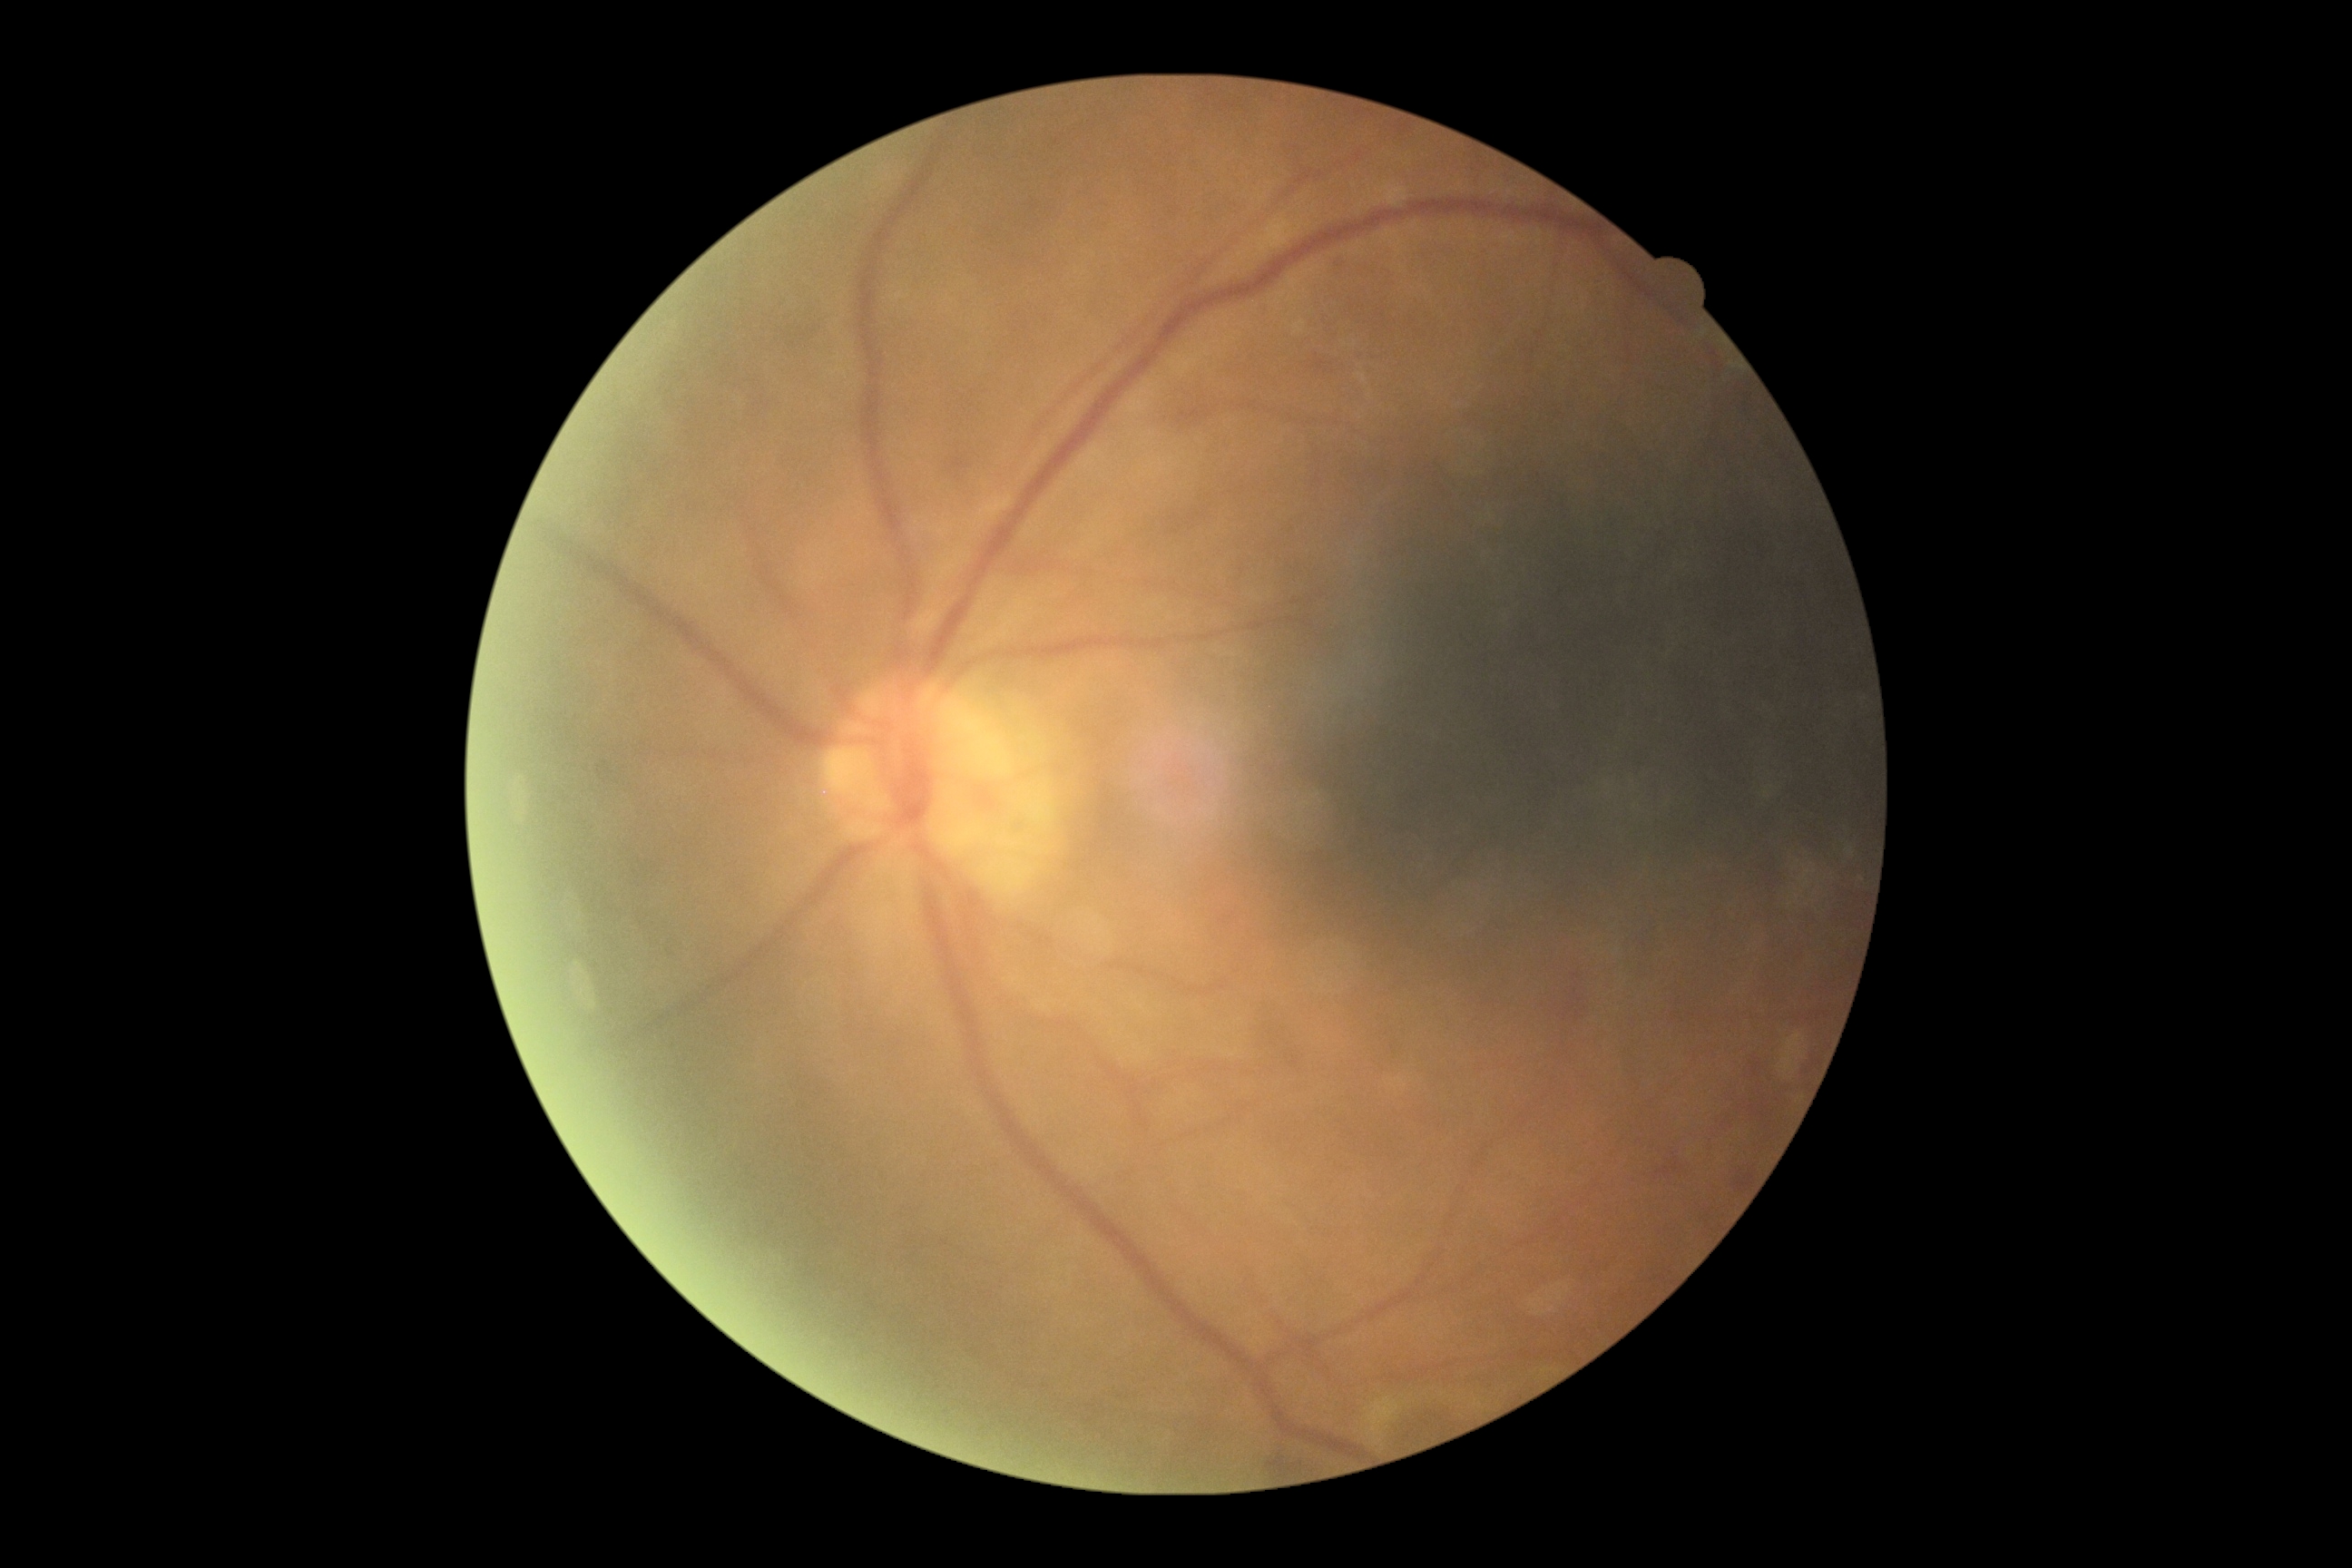

Diabetic retinopathy severity: grade 2 (moderate NPDR).